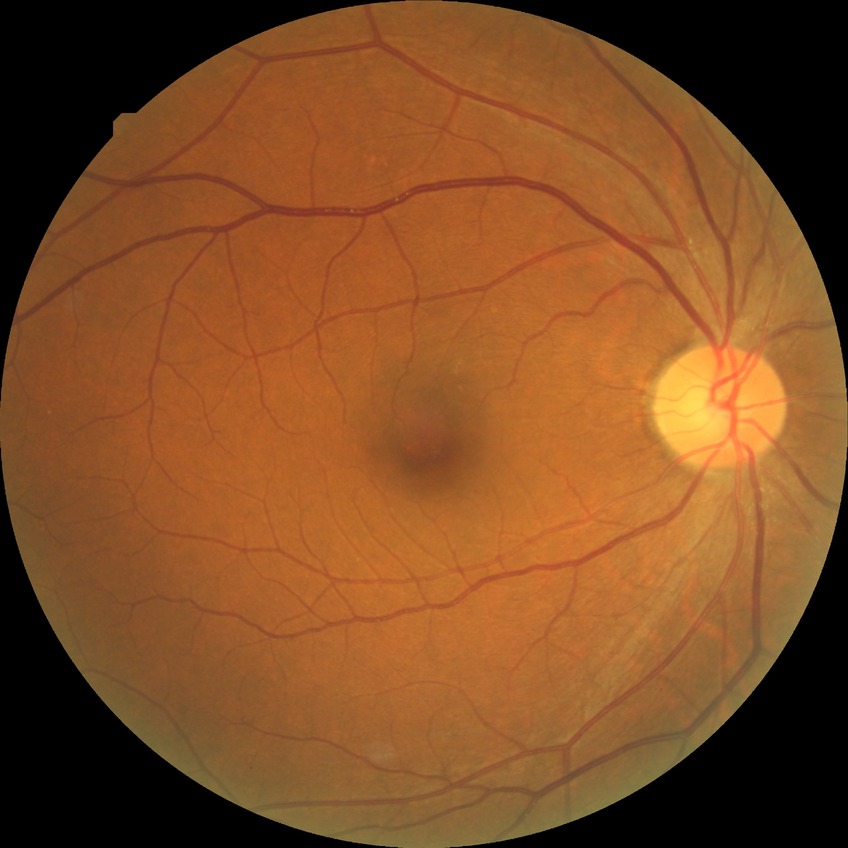
Assessment:
• diabetic retinopathy severity: no diabetic retinopathy